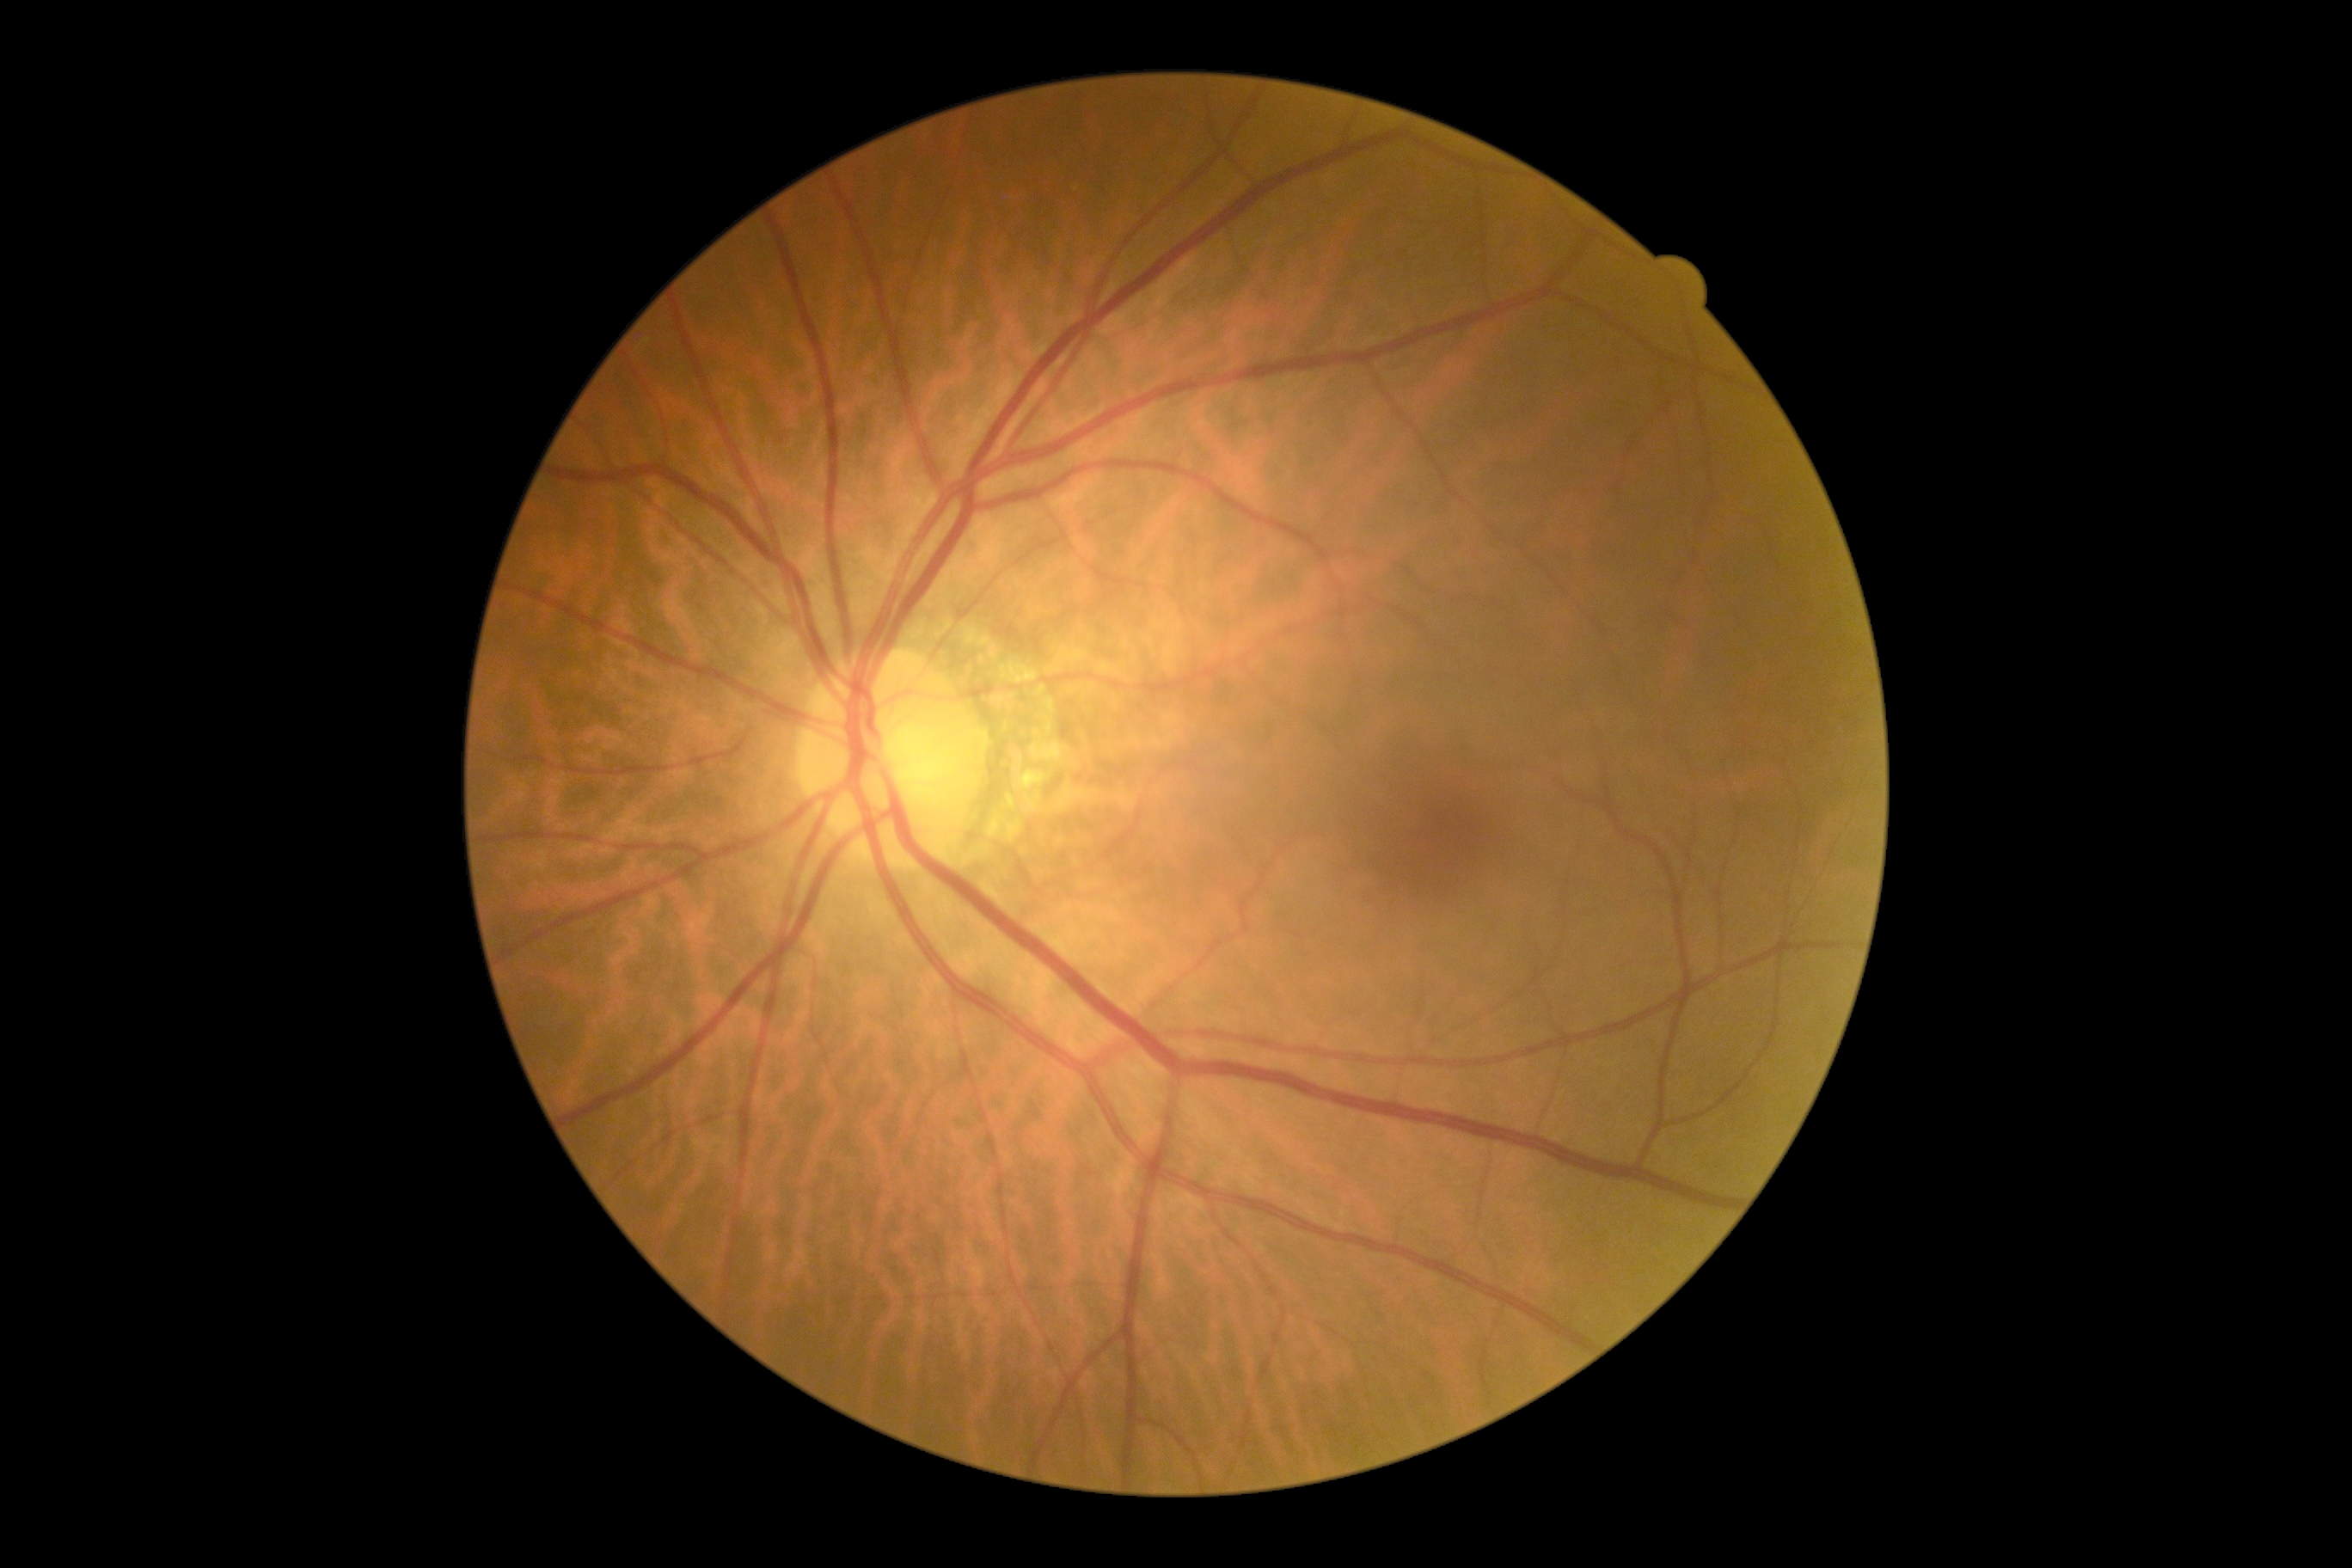
{
  "dr_impression": "no apparent DR",
  "dr_grade": "0 (no apparent retinopathy)"
}